Modified Davis classification:
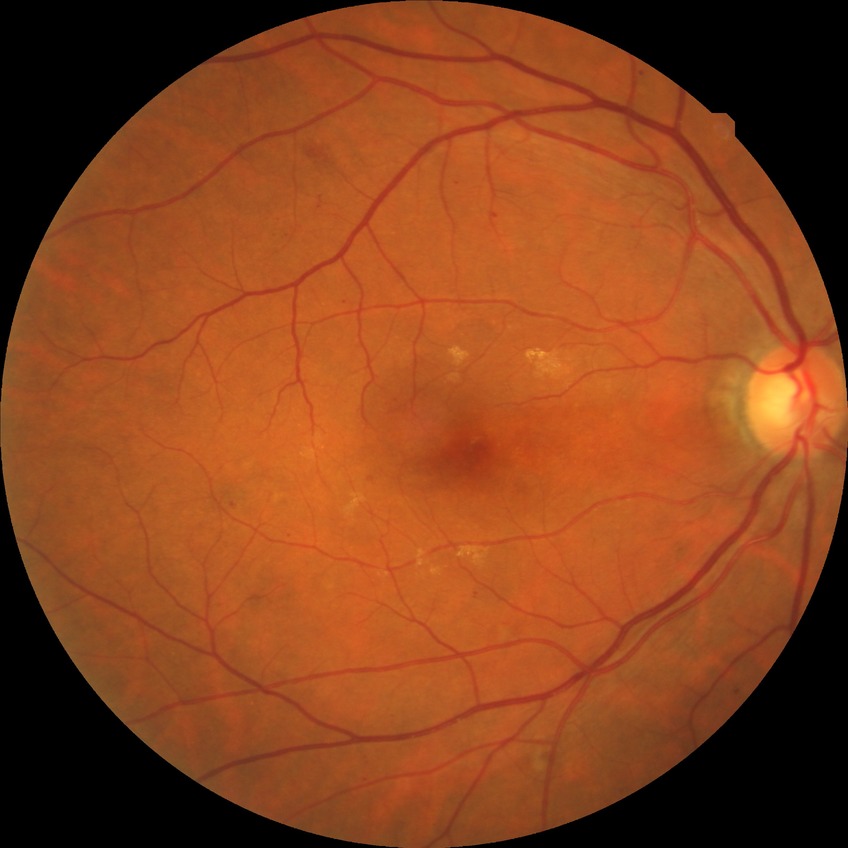 retinopathy grade: simple diabetic retinopathy.